Wide-field fundus photograph from neonatal ROP screening.
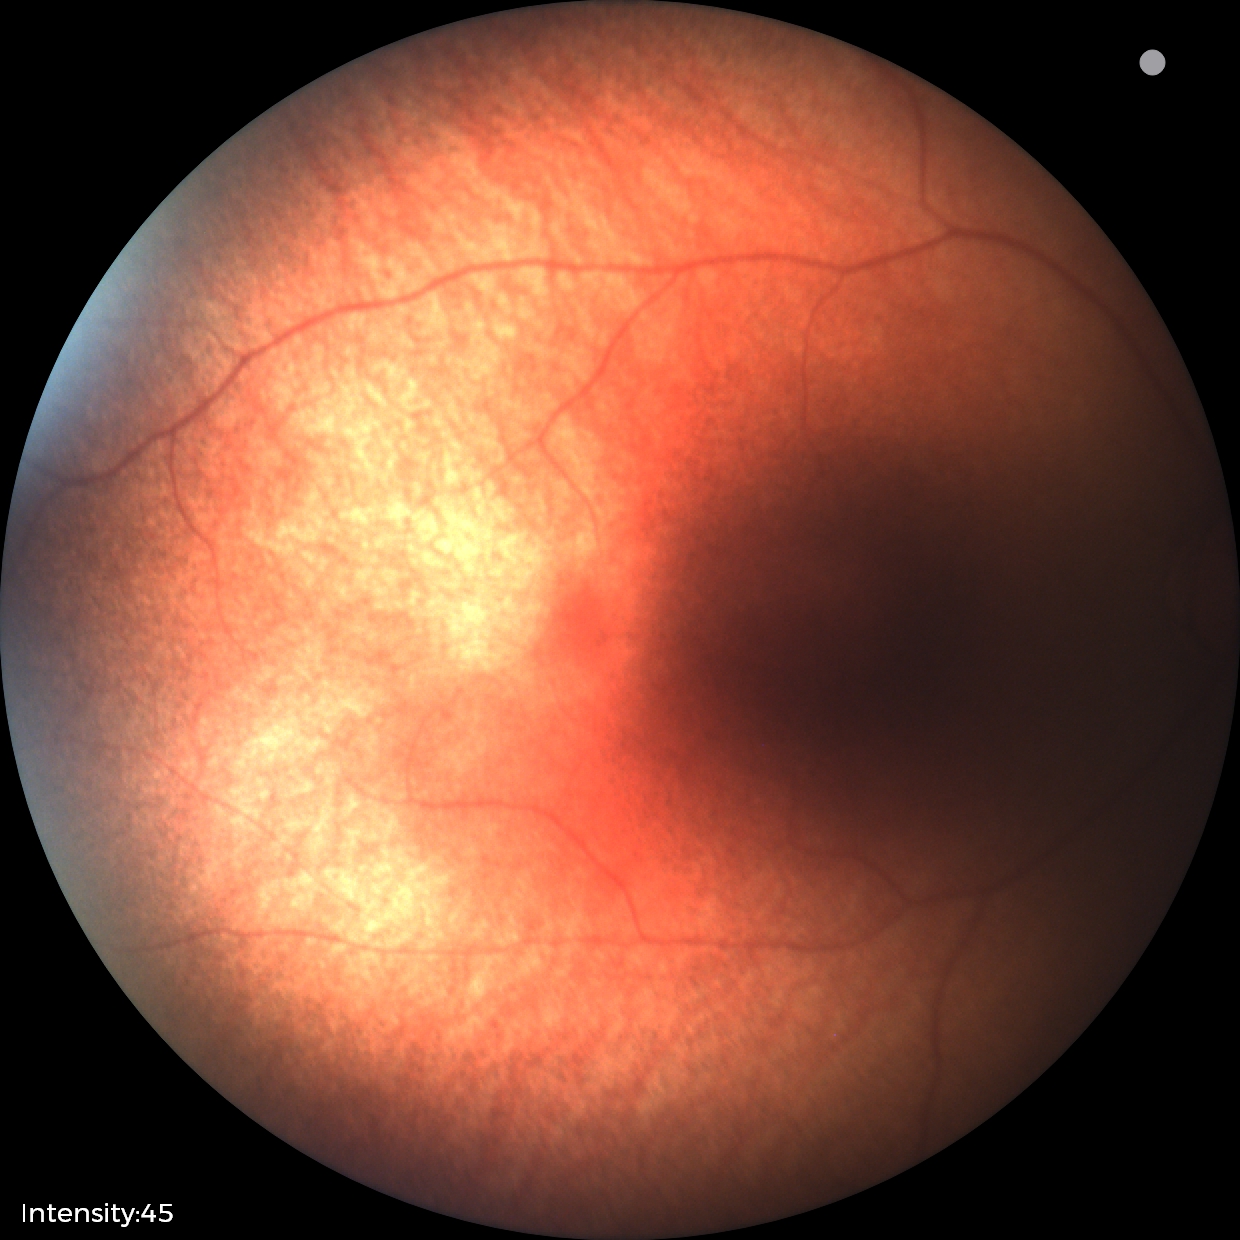 Impression: no pathology identified.